Color fundus photograph from a handheld portable camera: 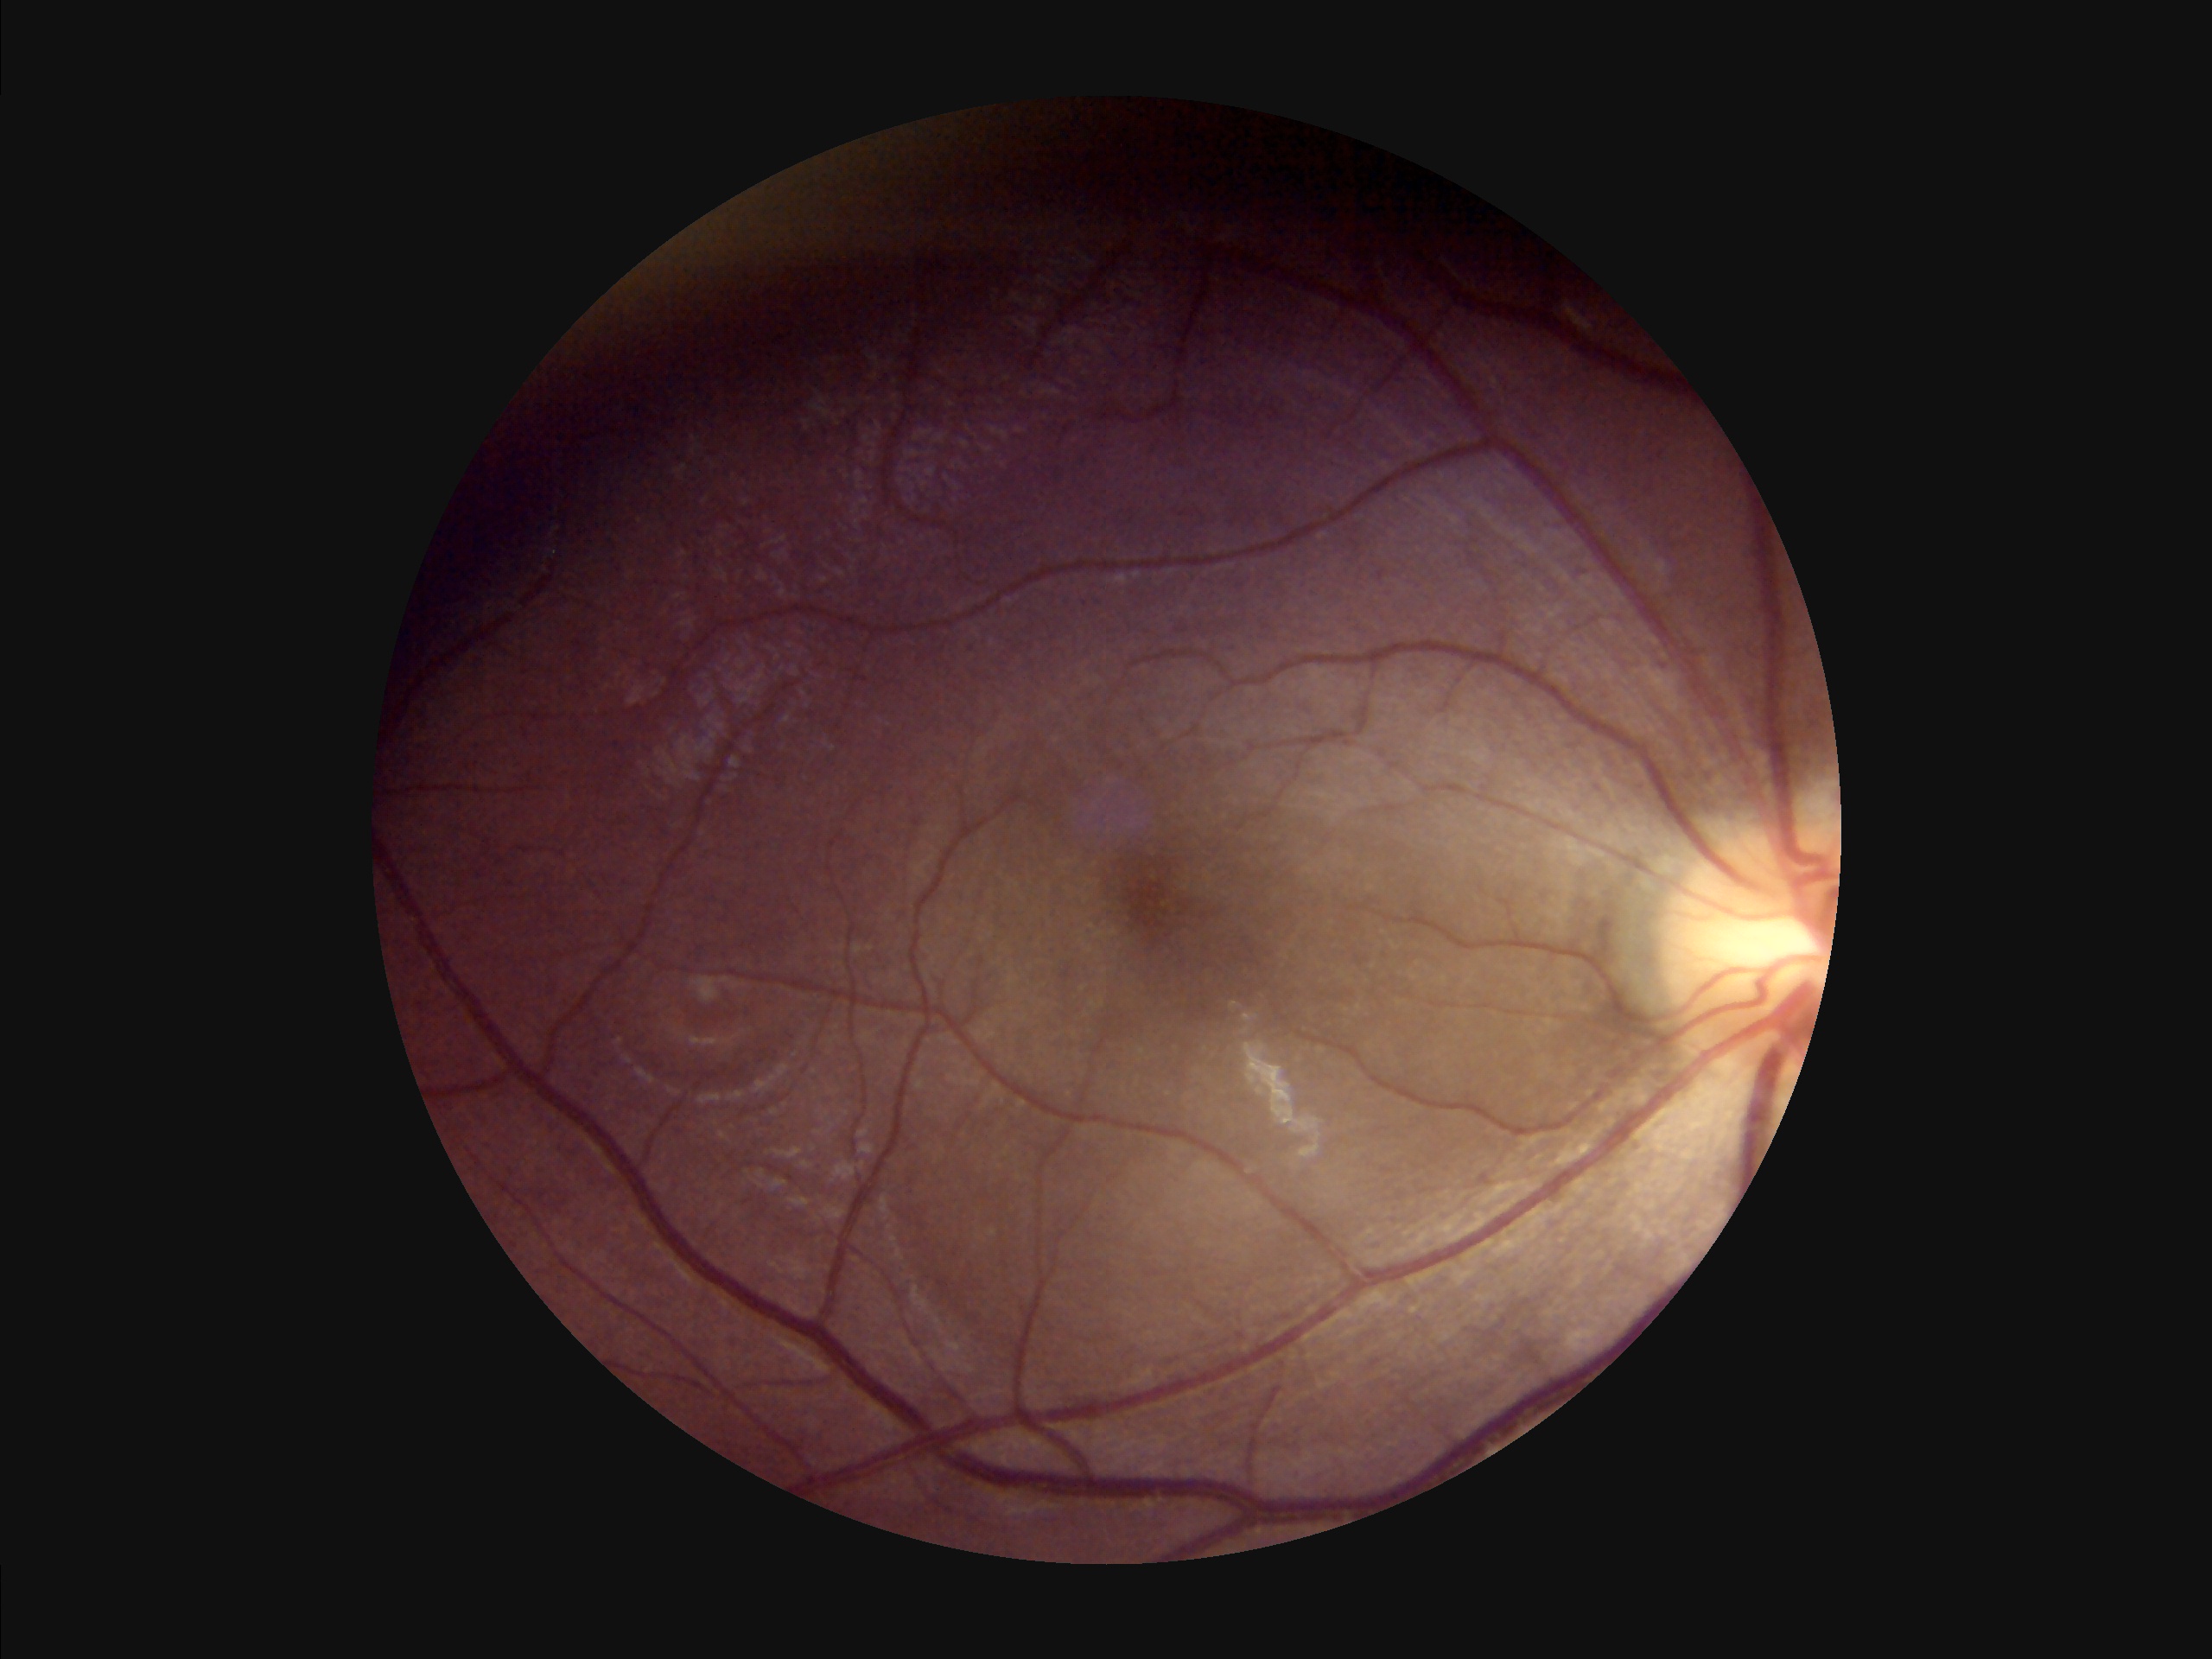 {"overall_quality": "inadequate", "clarity": "in focus", "illumination": "uneven", "contrast": "satisfactory"}